Retinal fundus photograph — 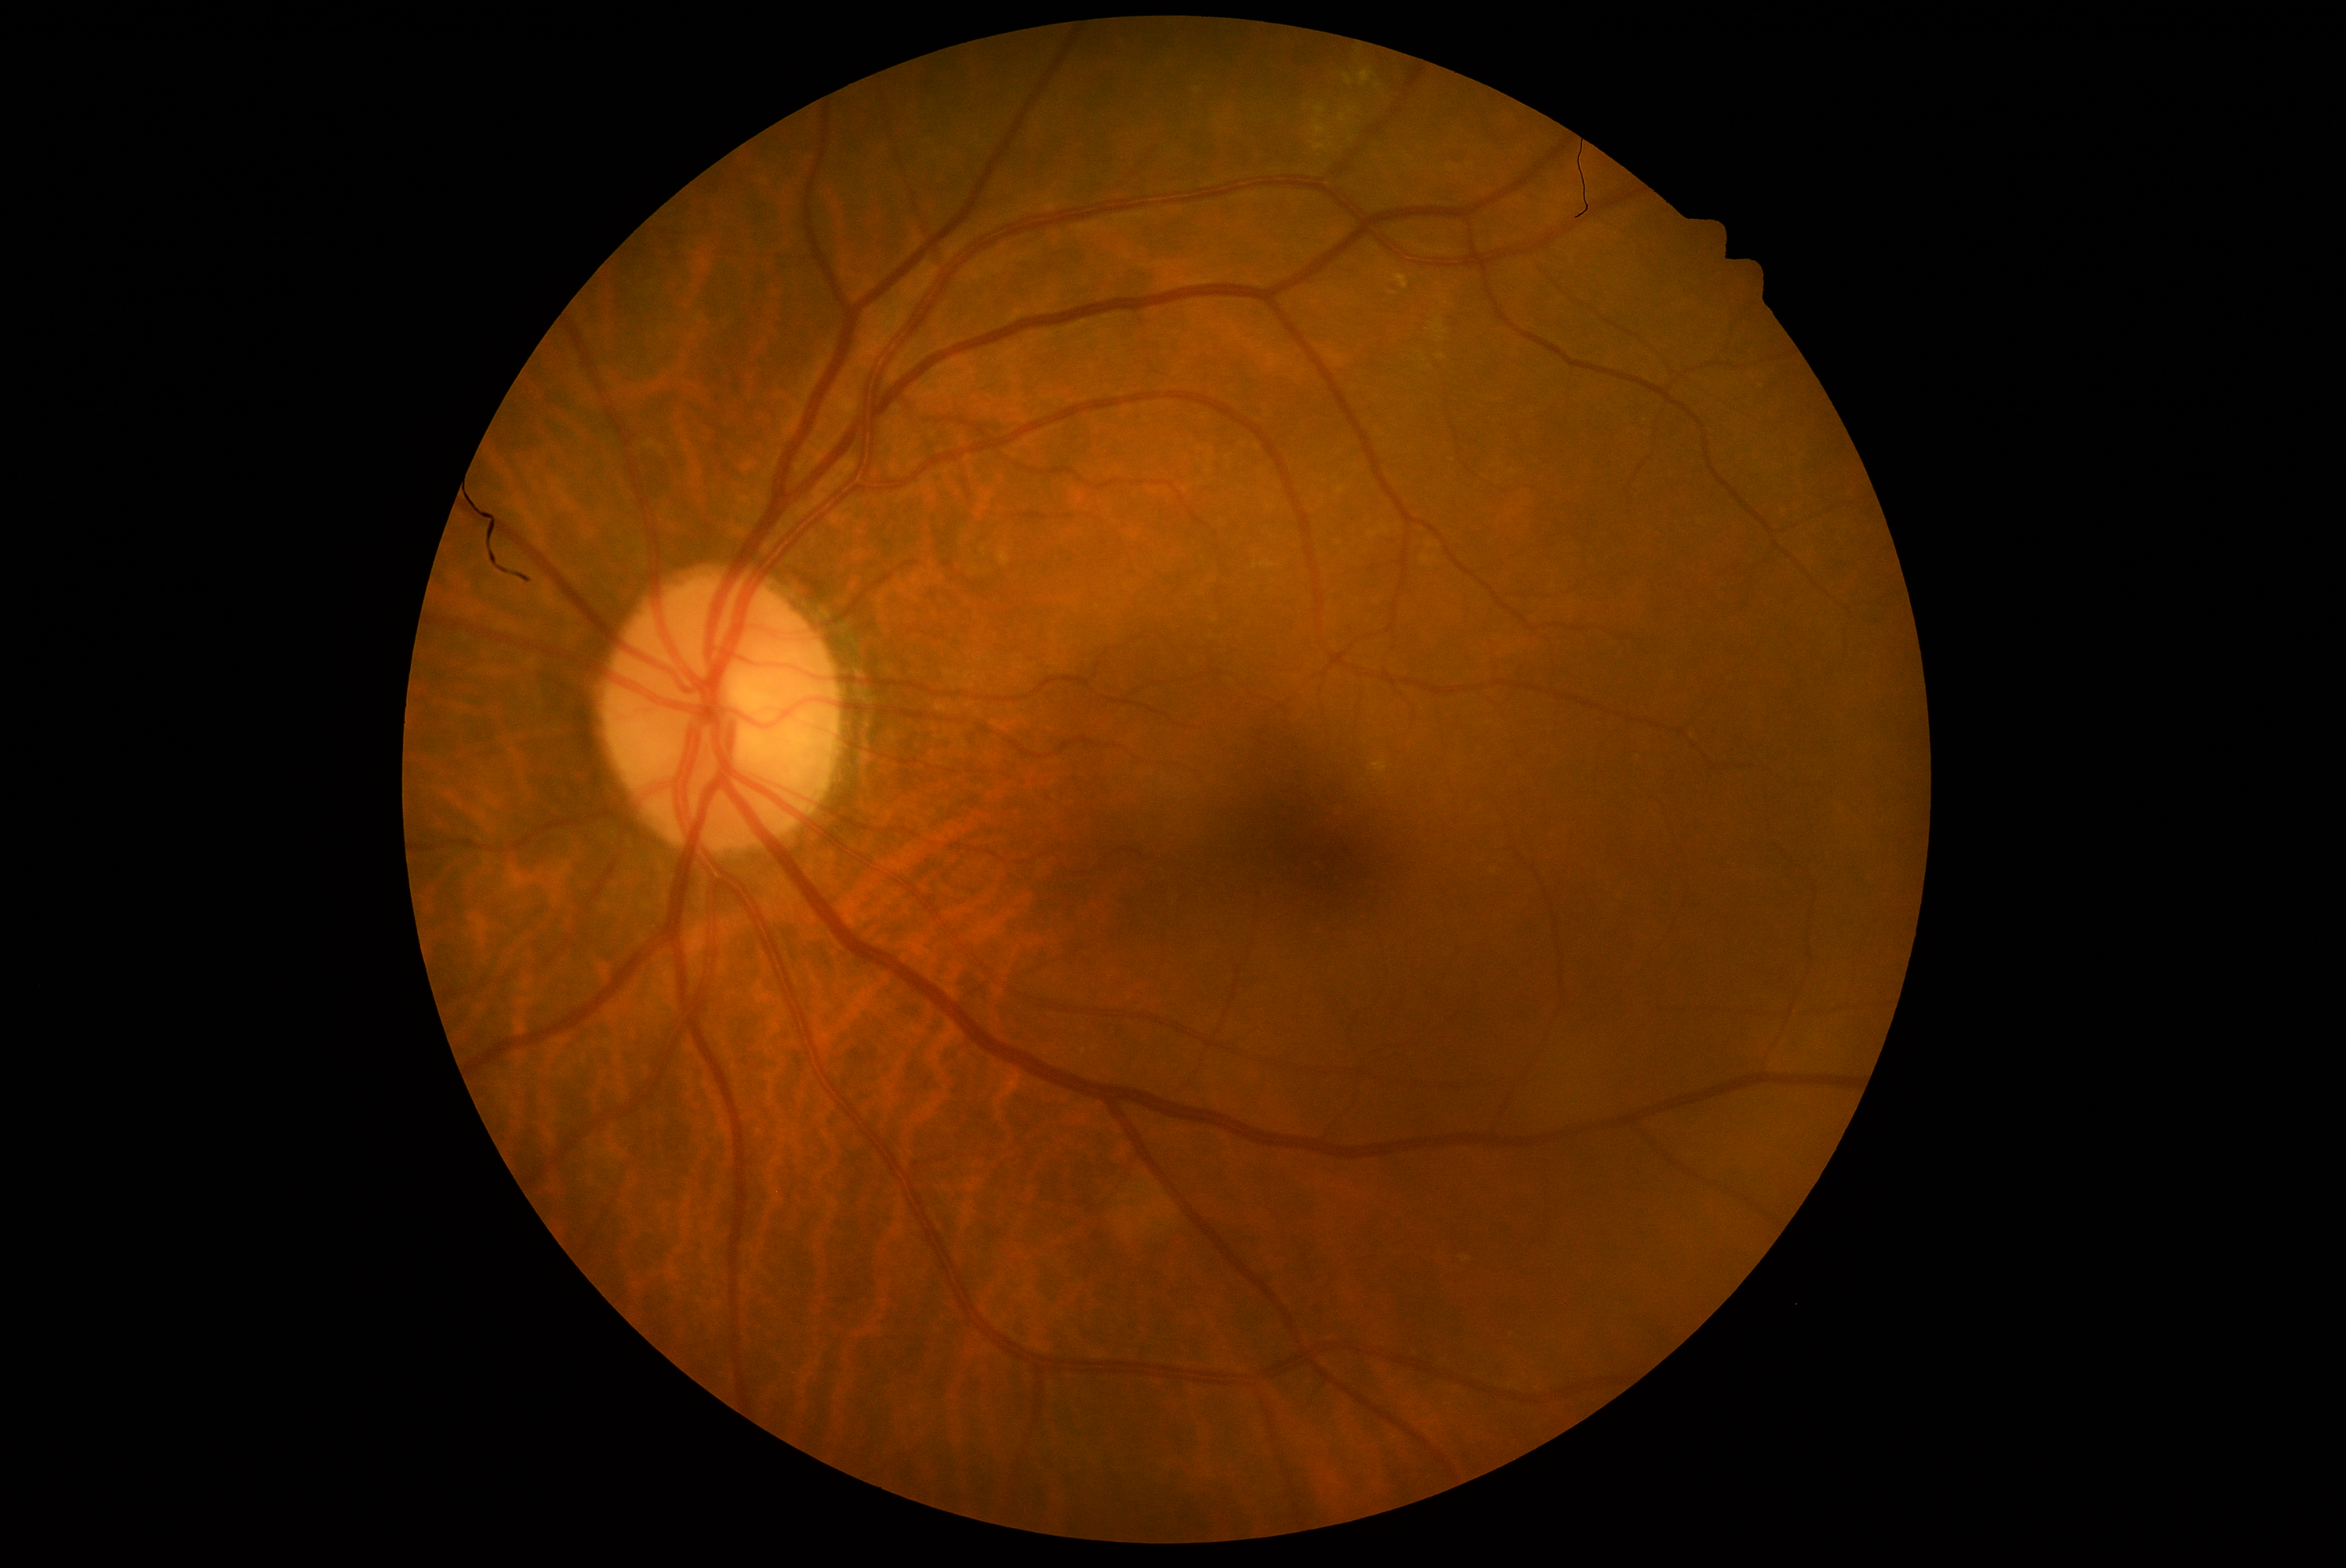 DR is 0/4.